Acquired on the Phoenix ICON; wide-field contact fundus photograph of an infant
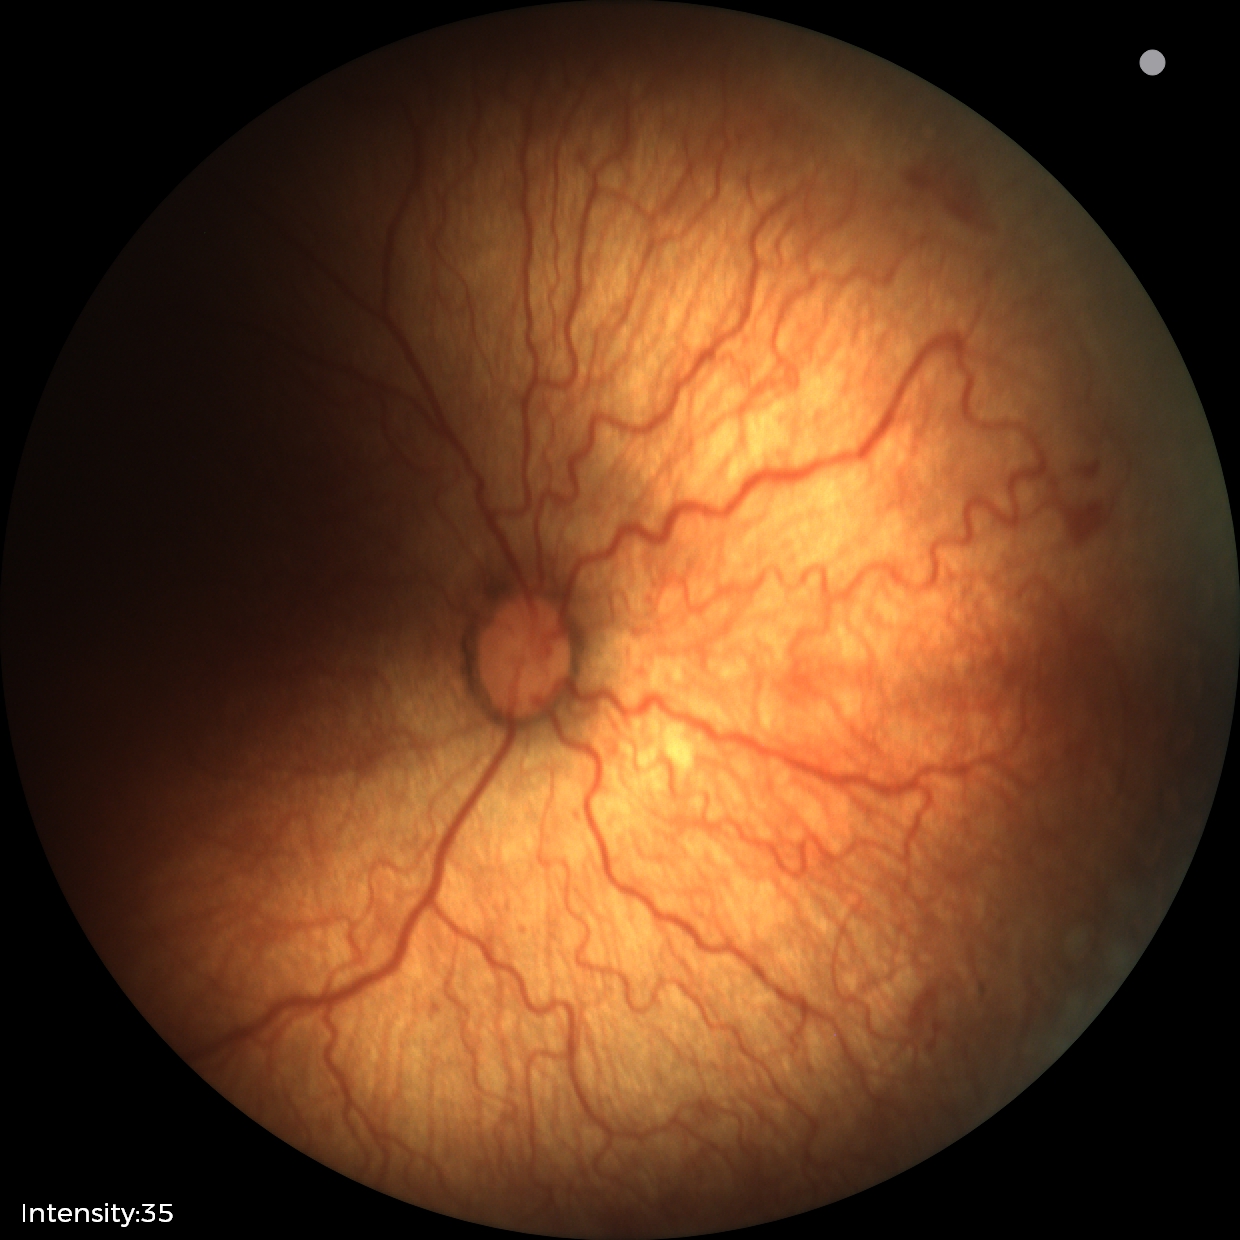
Screening diagnosis: plus disease; retinopathy of prematurity stage 2.